Fundus photo. 2352 x 1568 pixels
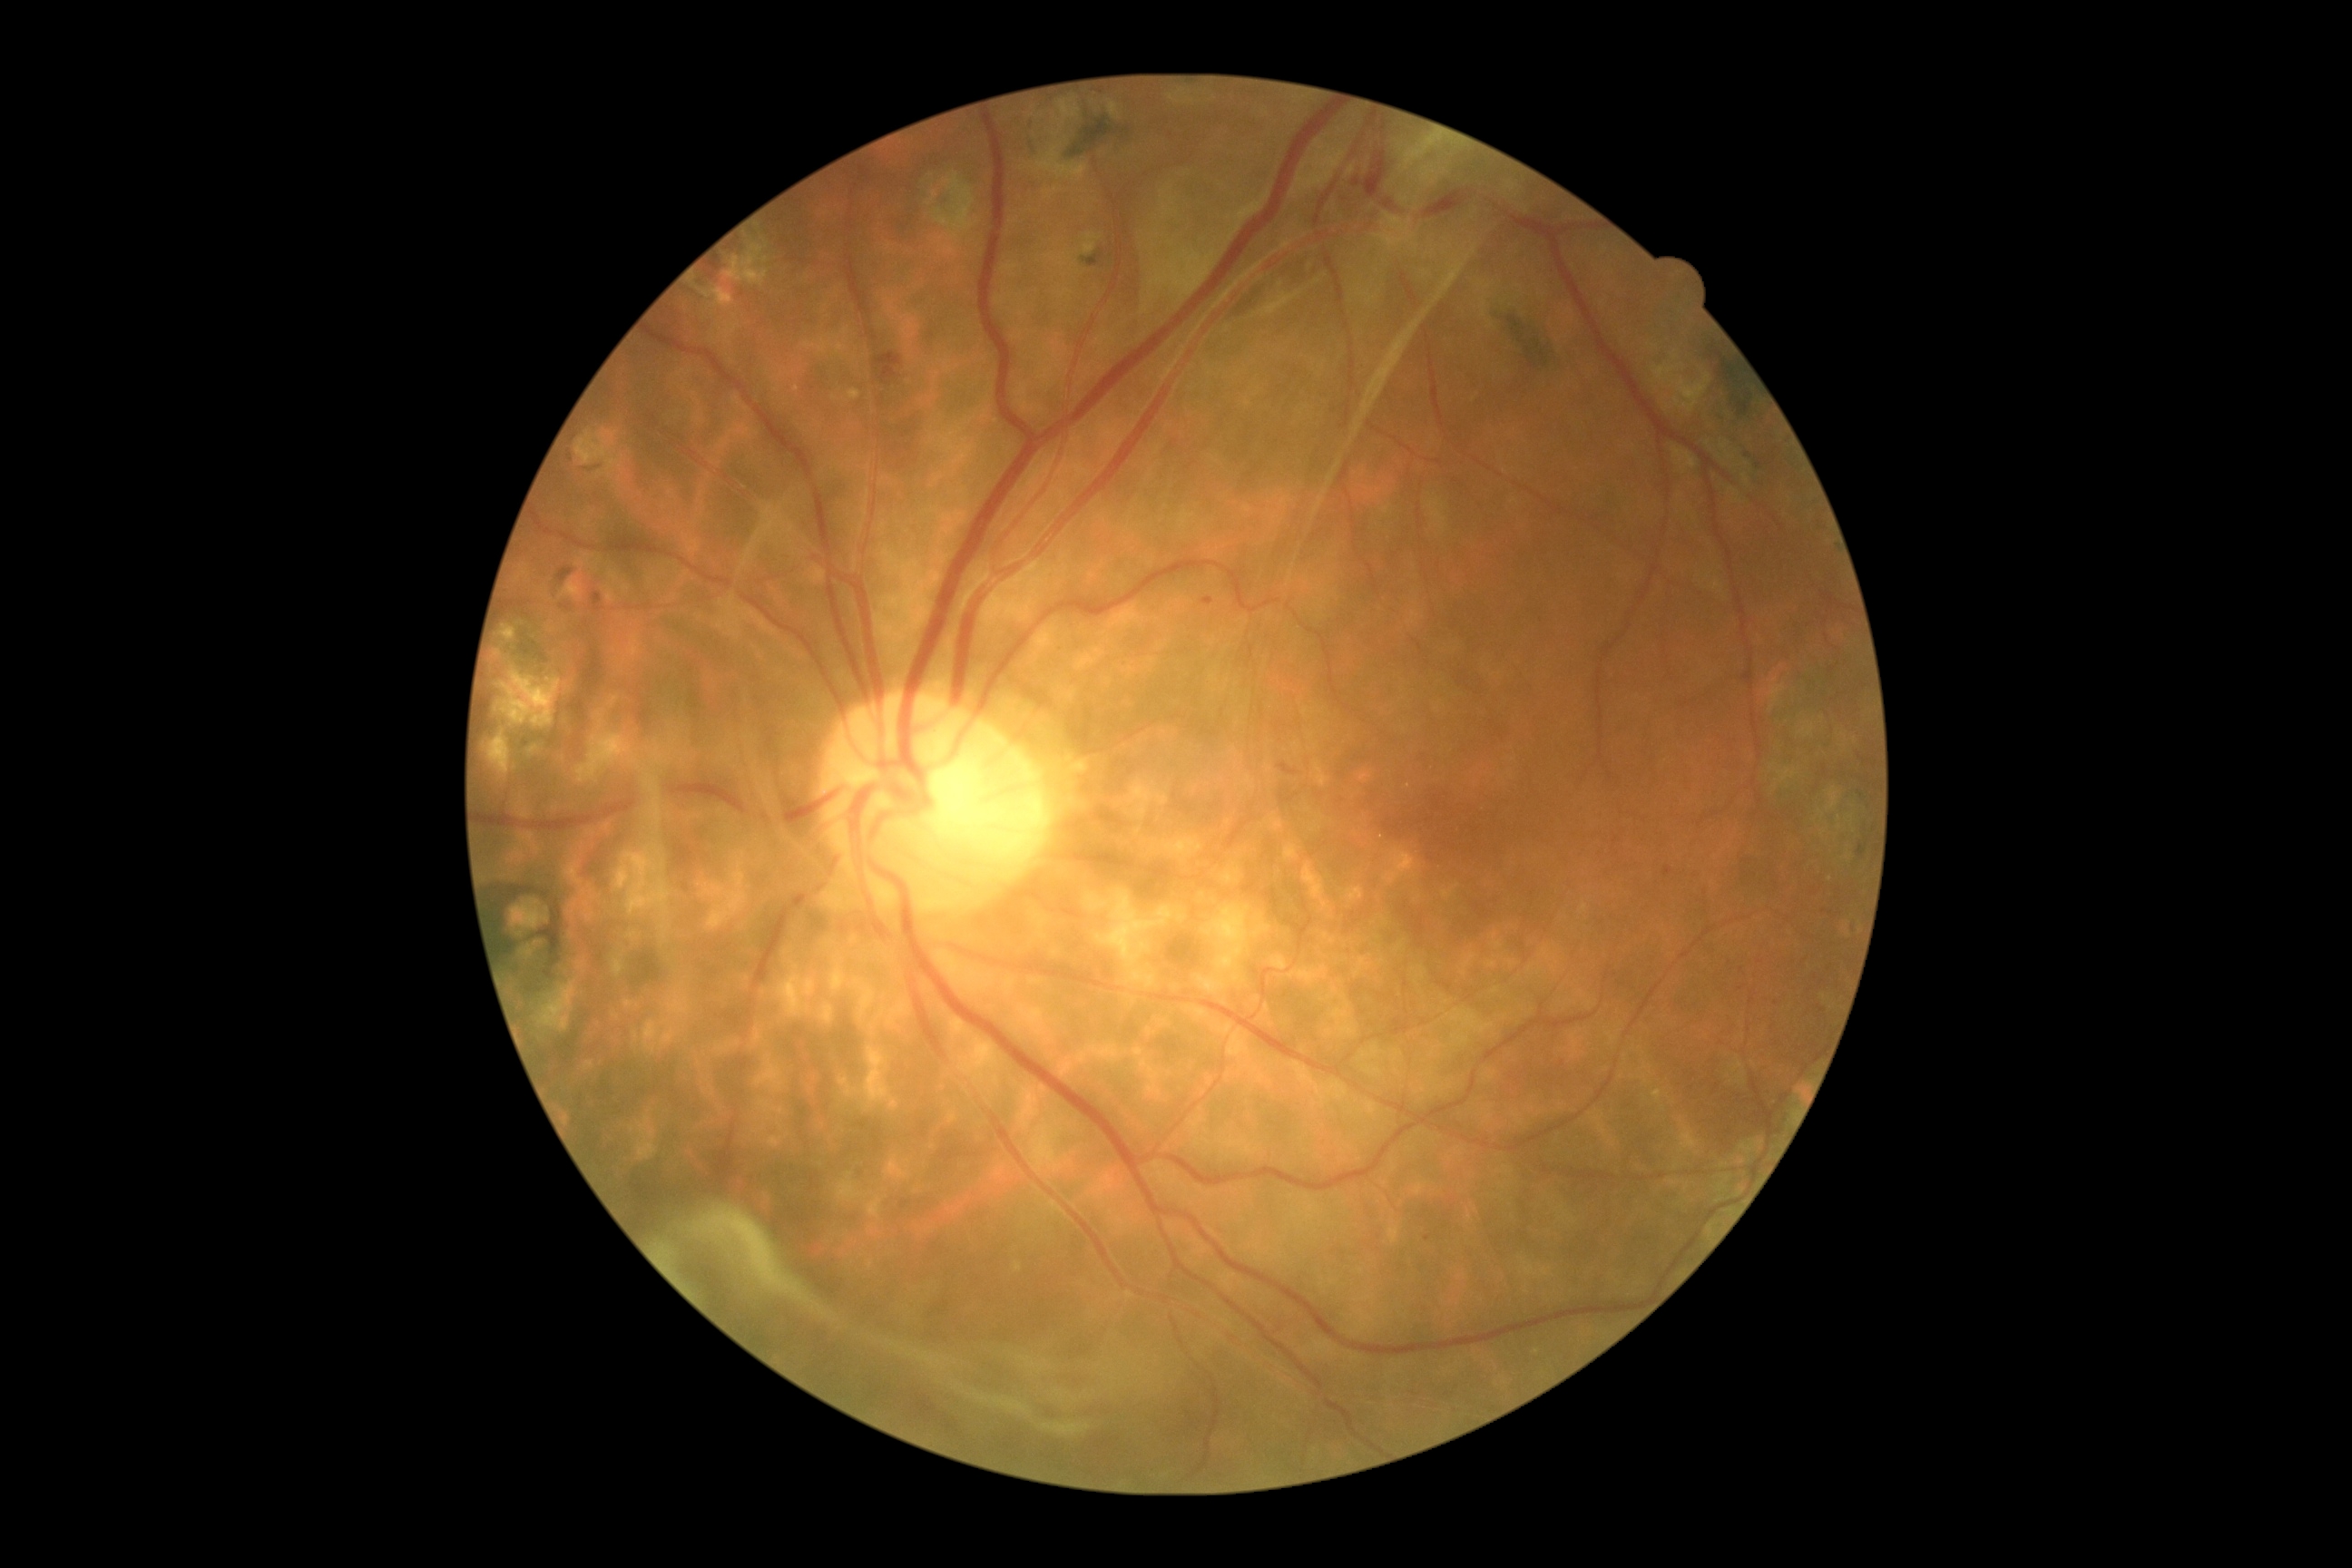

• diabetic retinopathy grade: 4/4